Ultra-widefield fundus photograph:
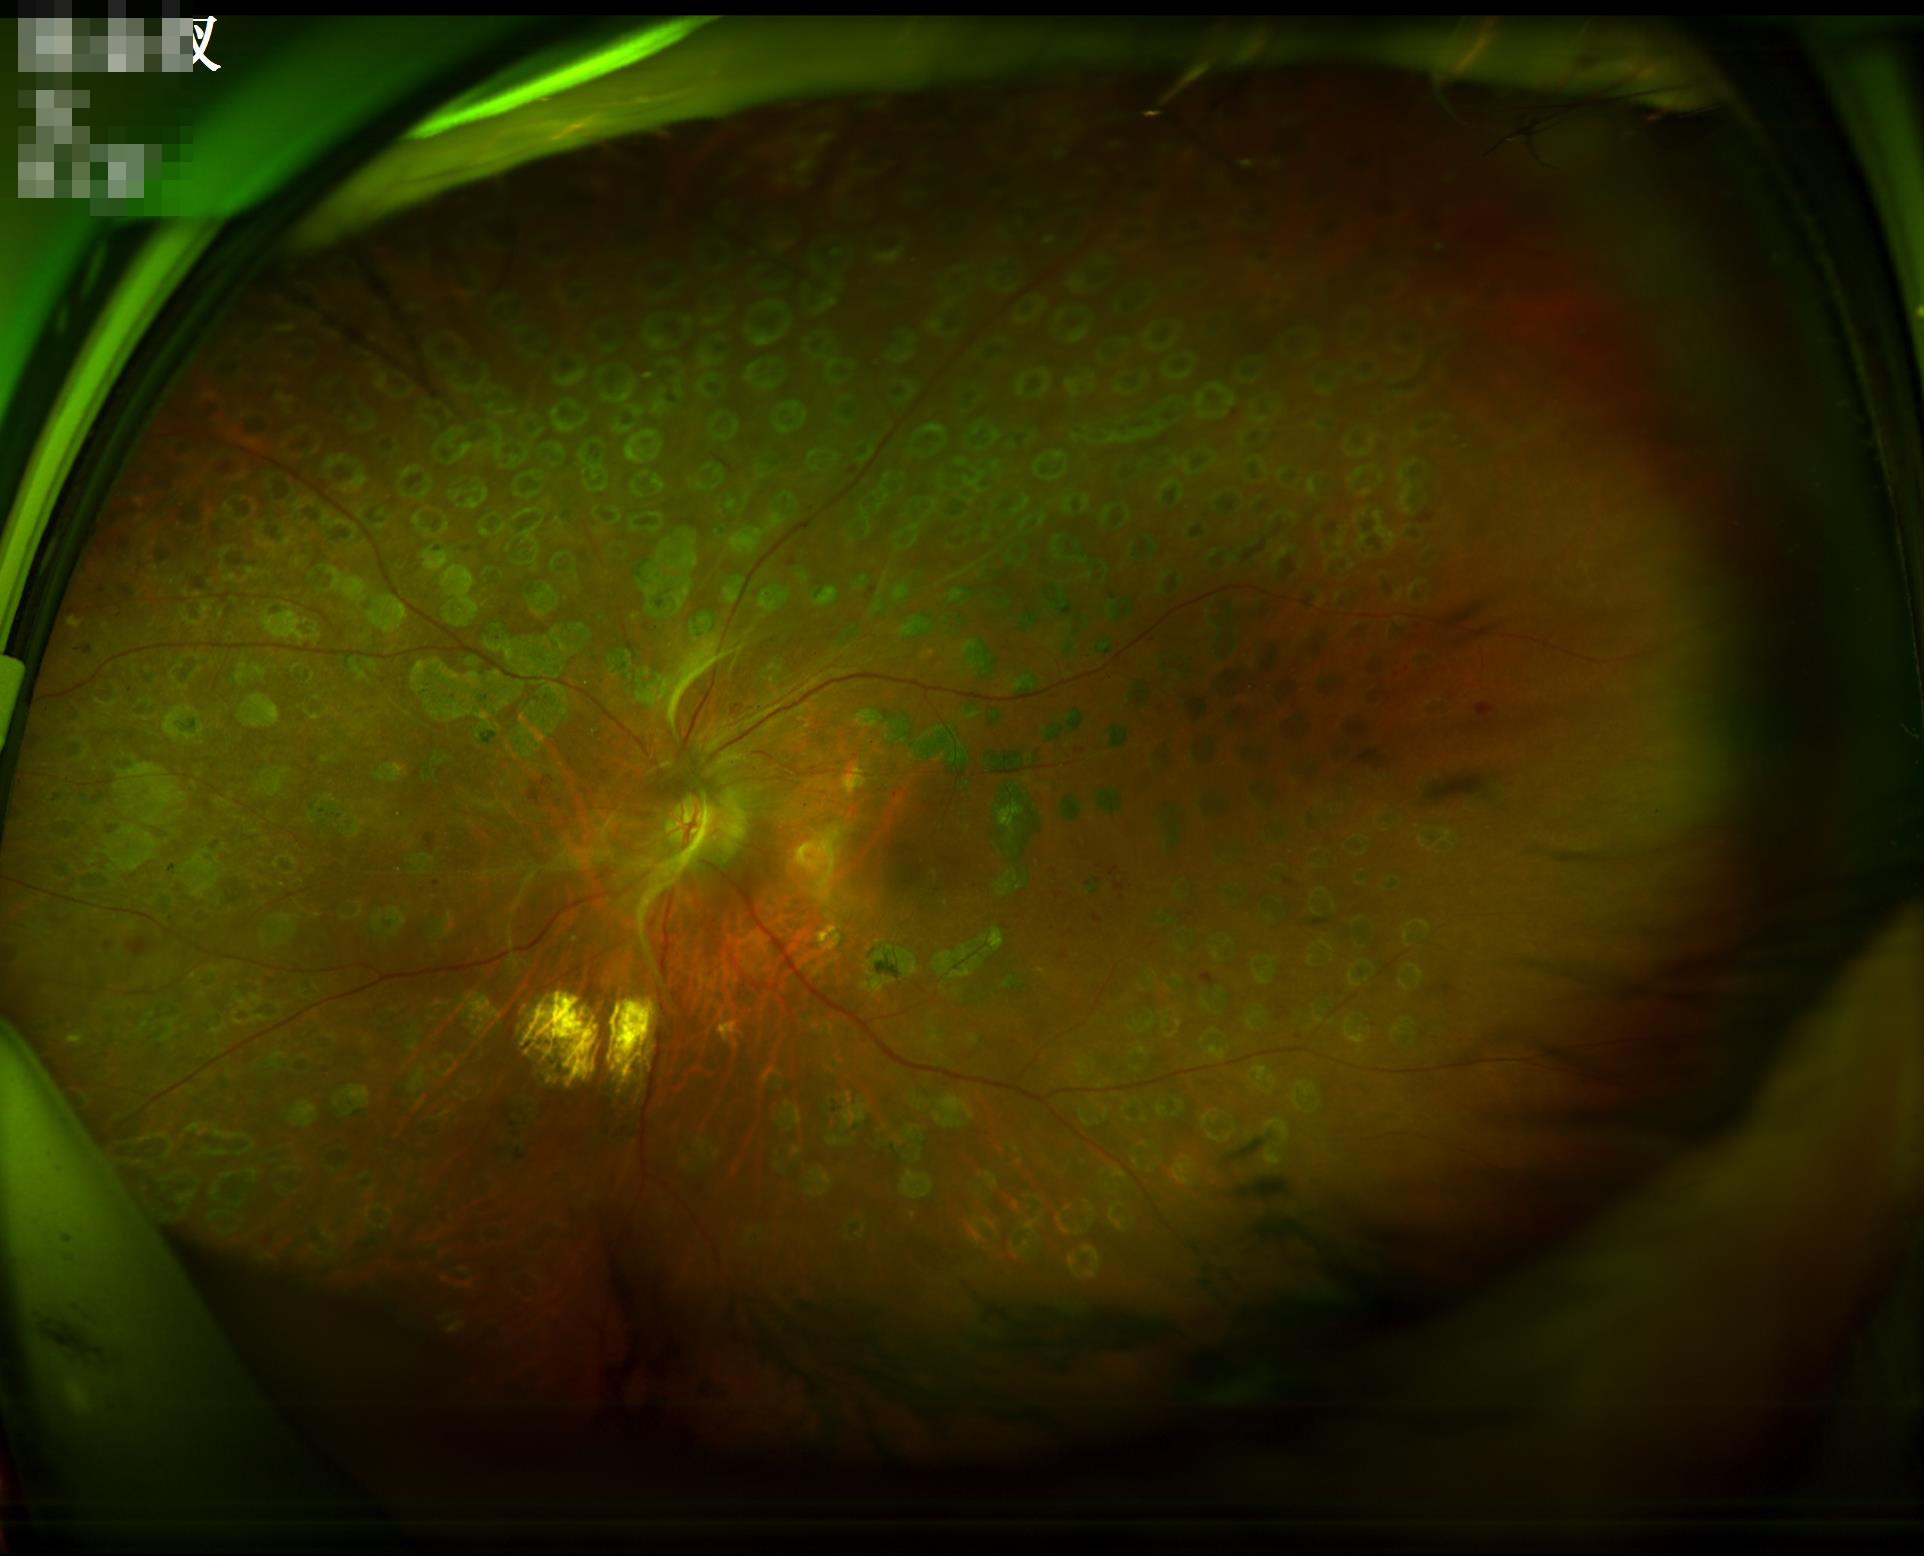 Image is sharp throughout the field.
Illumination and color balance are good.